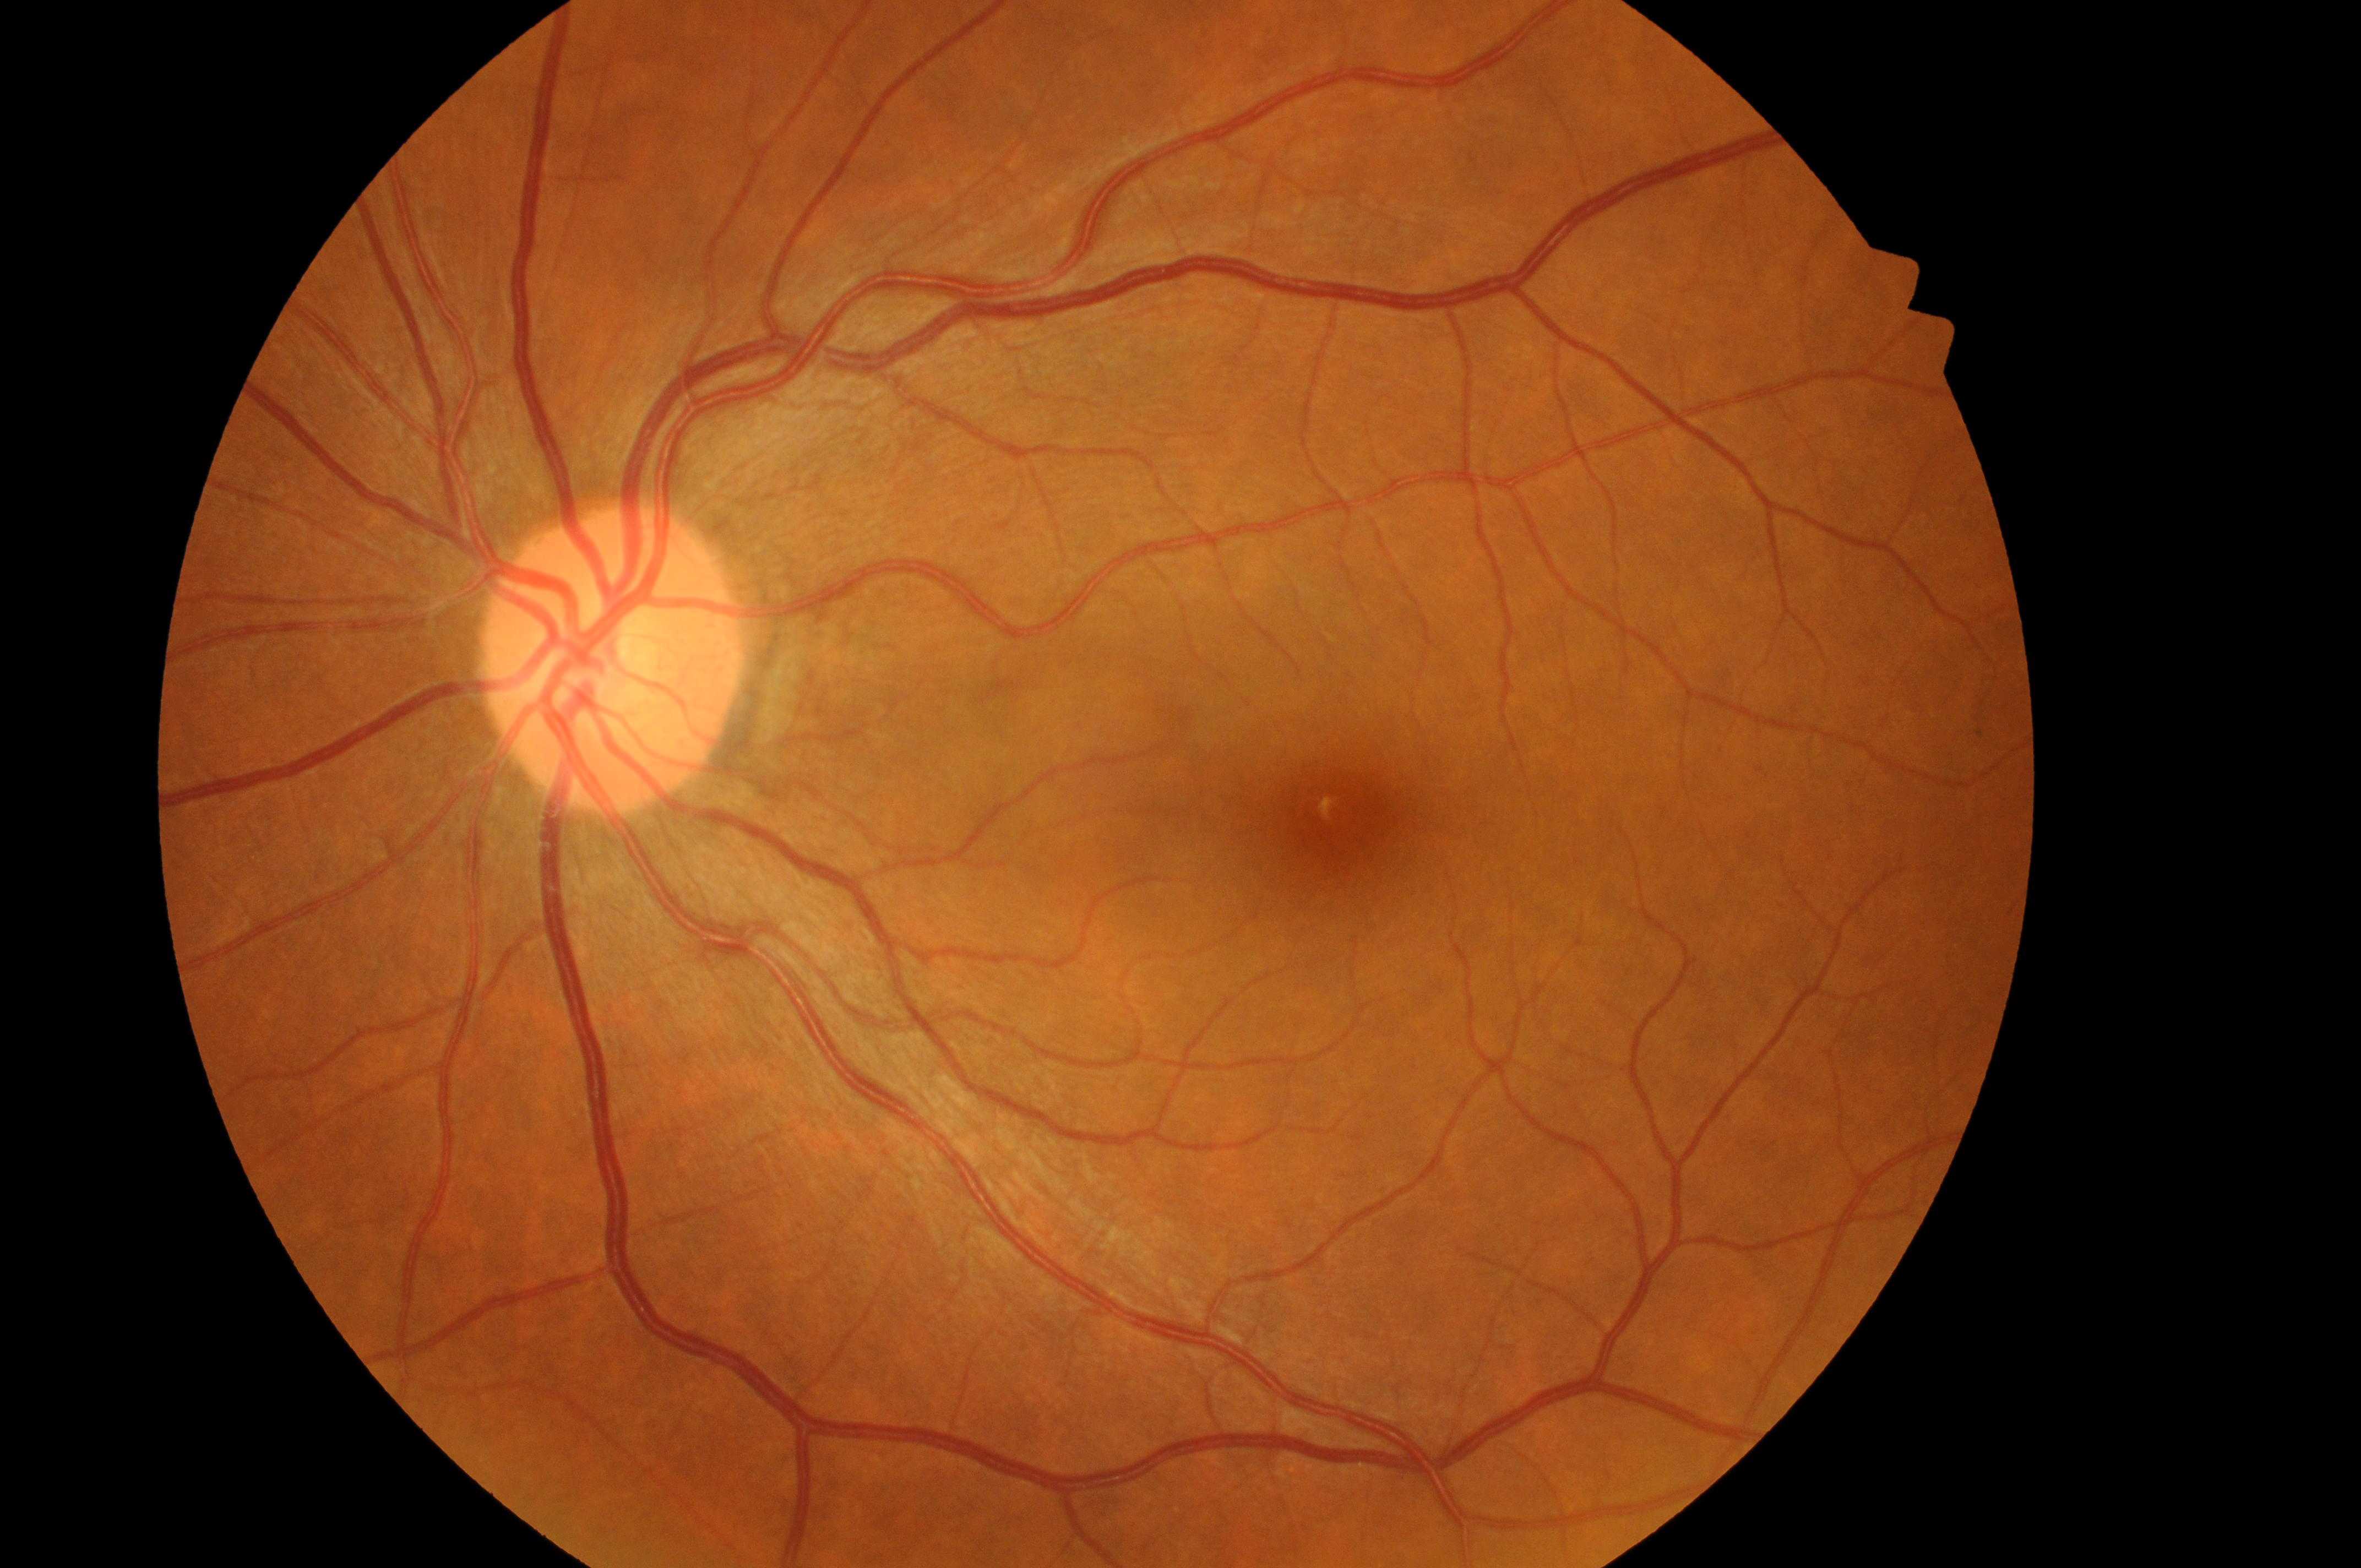
{"optic_disc": "604, 672", "dme_grade": "no risk (grade 0)", "eye": "the left eye", "fovea": "1341, 816", "dr_grade": "no apparent retinopathy (grade 0)"}